Fundus photo, NIDEK AFC-230 fundus camera, no pharmacologic dilation
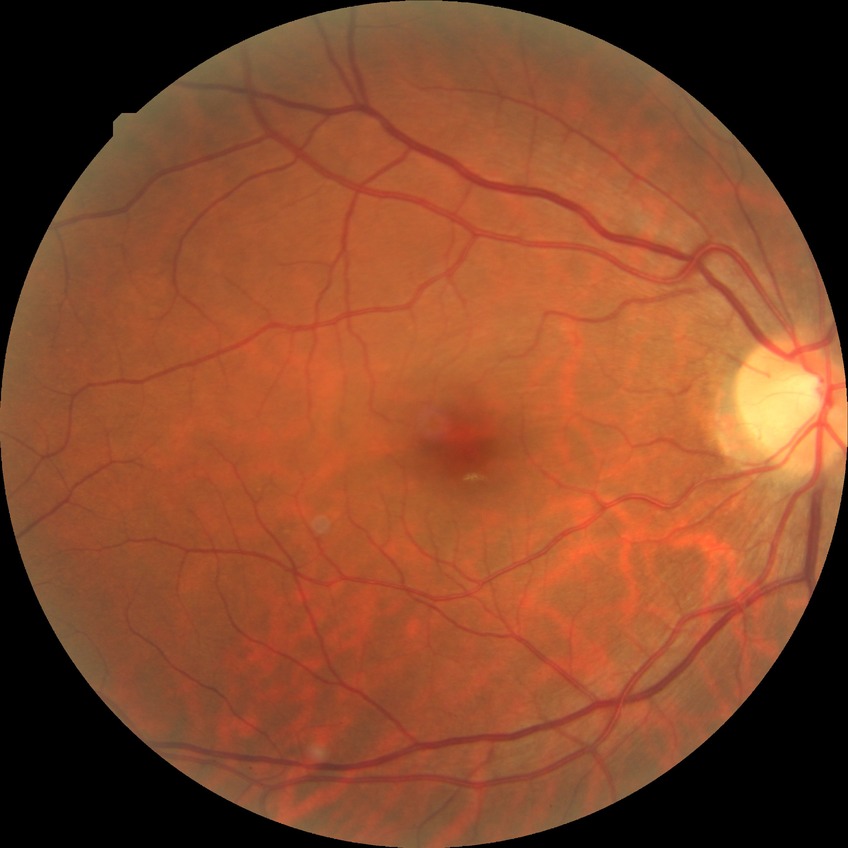 Diabetic retinopathy (DR) is no diabetic retinopathy (NDR).